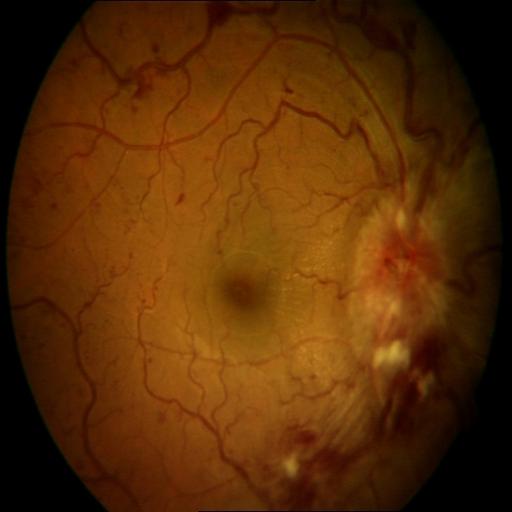
Abnormalities: central retinal vein occlusion.